640x480px · RetCam wide-field infant fundus image
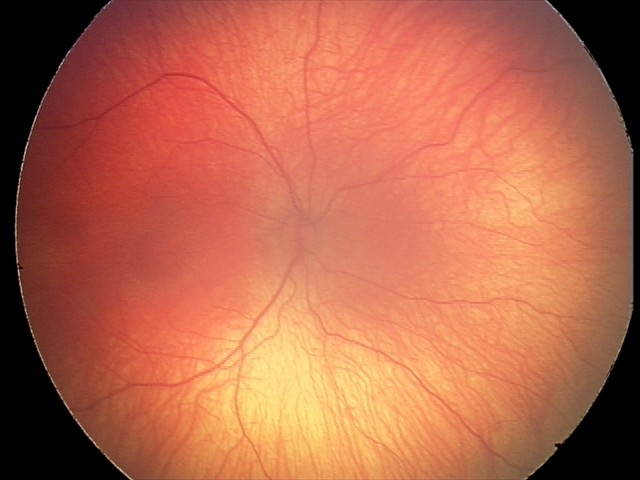 Q: What is the screening diagnosis?
A: ROP stage 2
Q: Is plus disease present?
A: no plus disease